45-degree field of view.
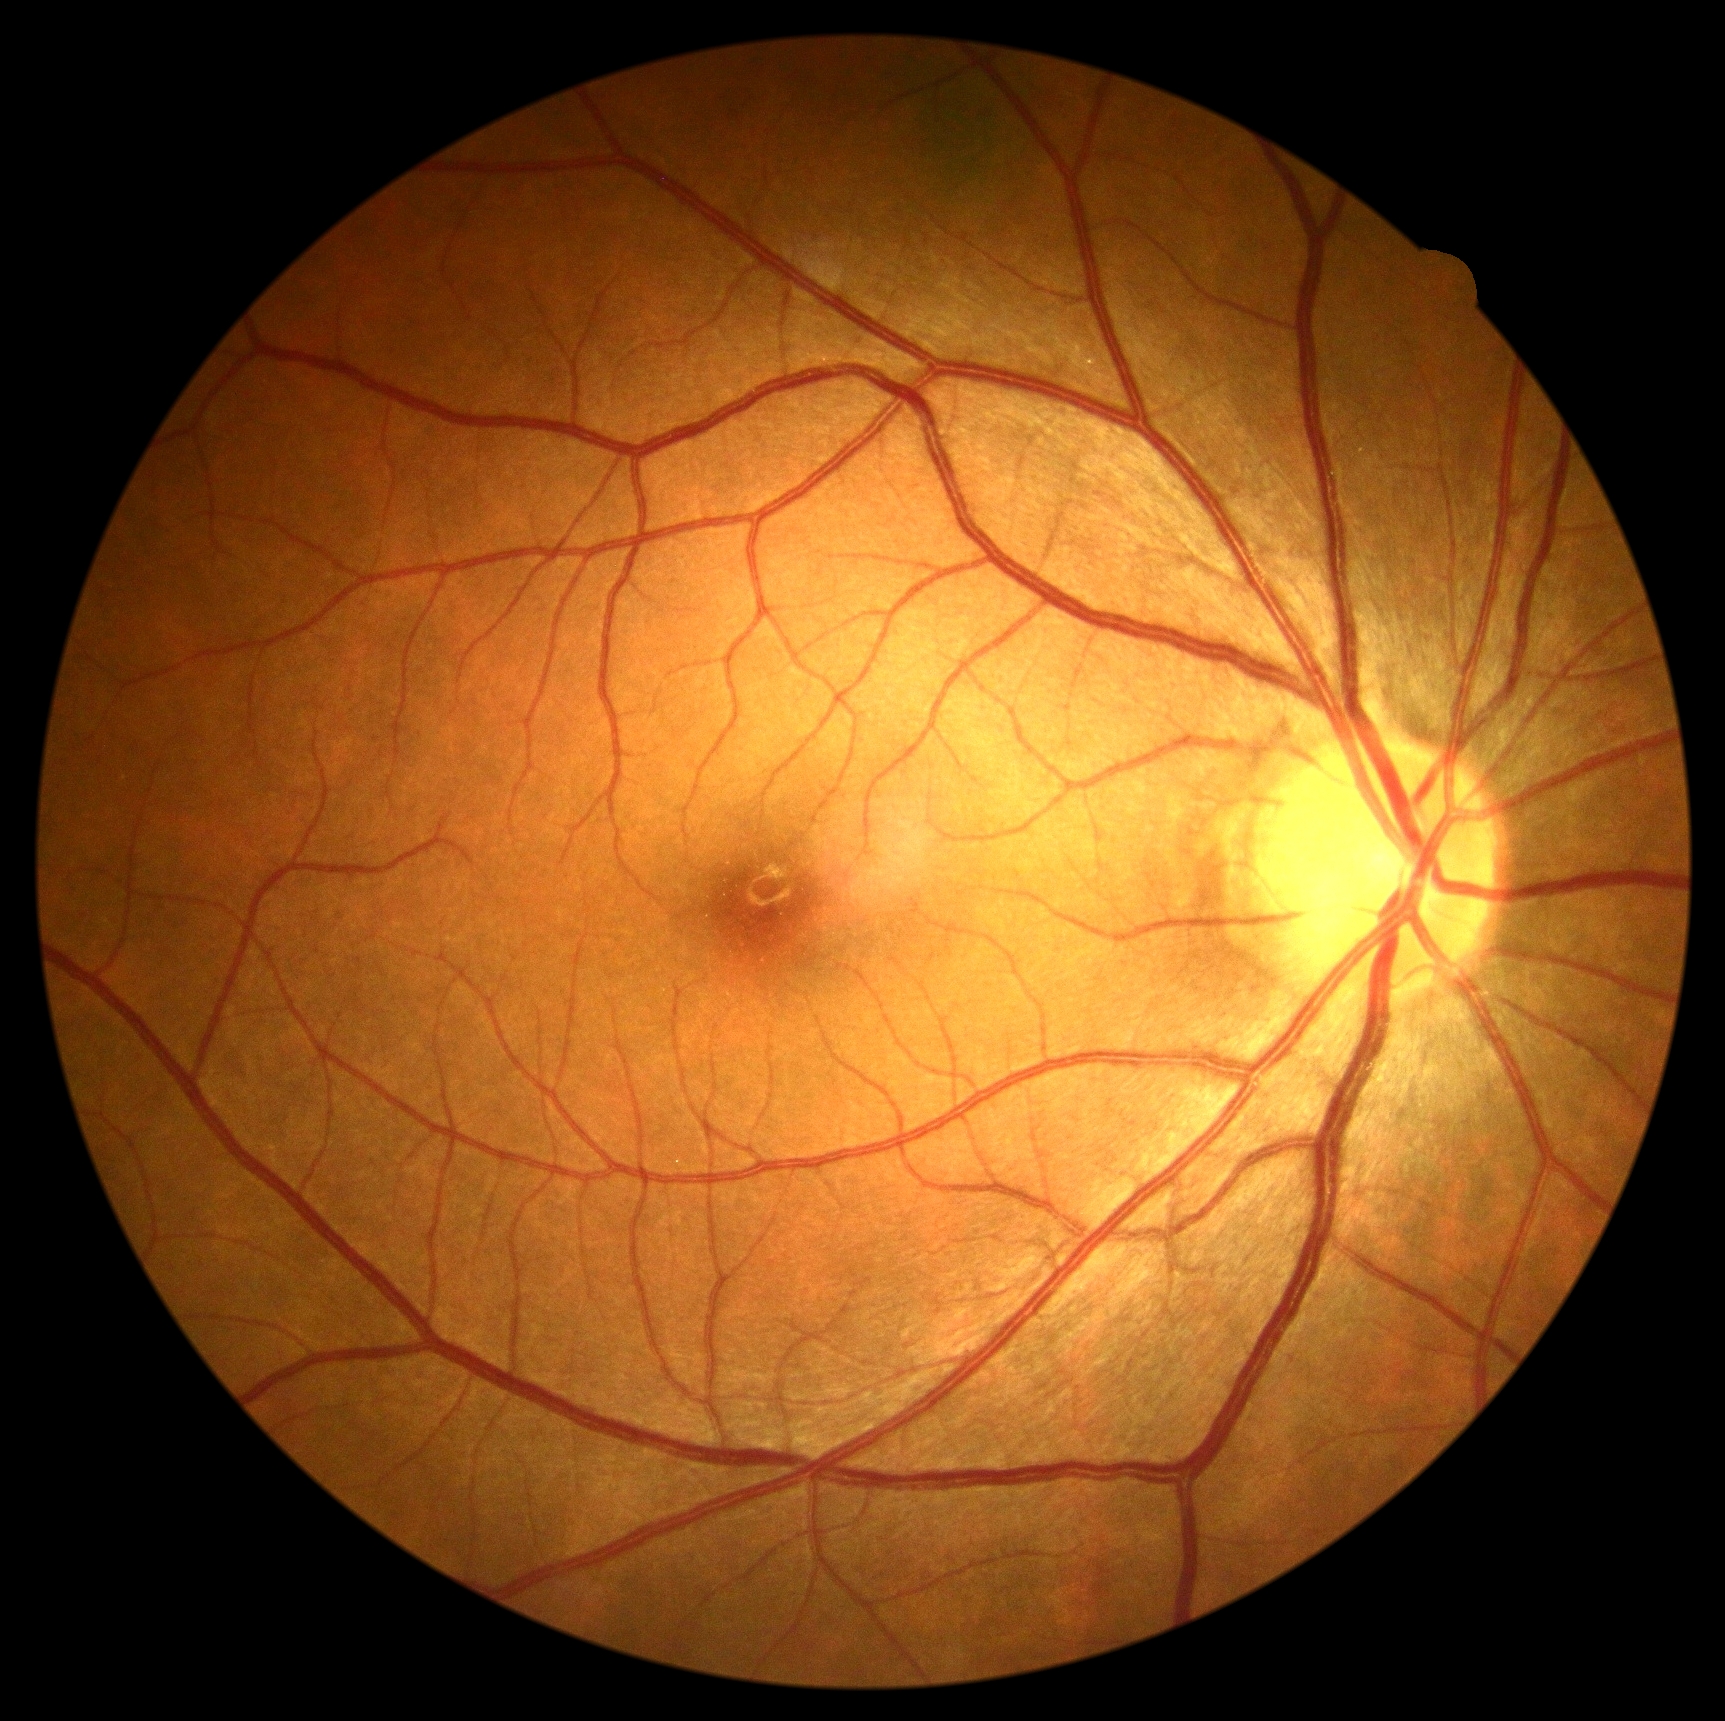

diabetic retinopathy (DR)@grade 0.